Wide-field fundus photograph from neonatal ROP screening; 130° field of view (Natus RetCam Envision); 1440 x 1080 pixels — 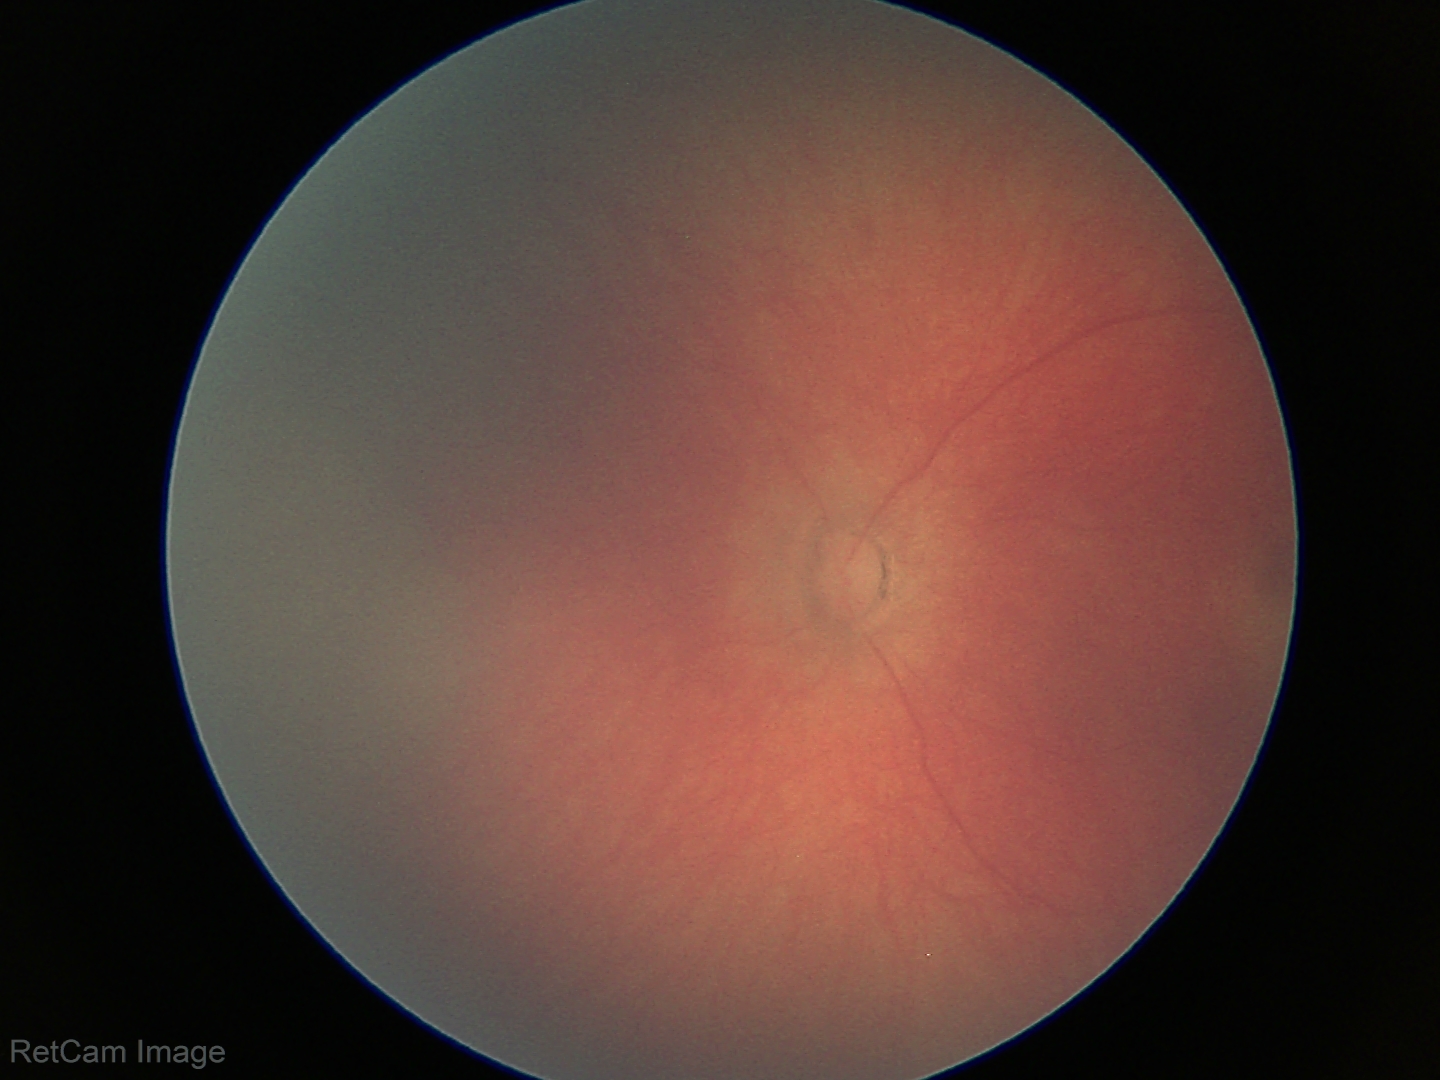 Screening examination diagnosed as physiological.